Wide-field fundus photograph of an infant; 1240x1240px; 100° field of view (Phoenix ICON):
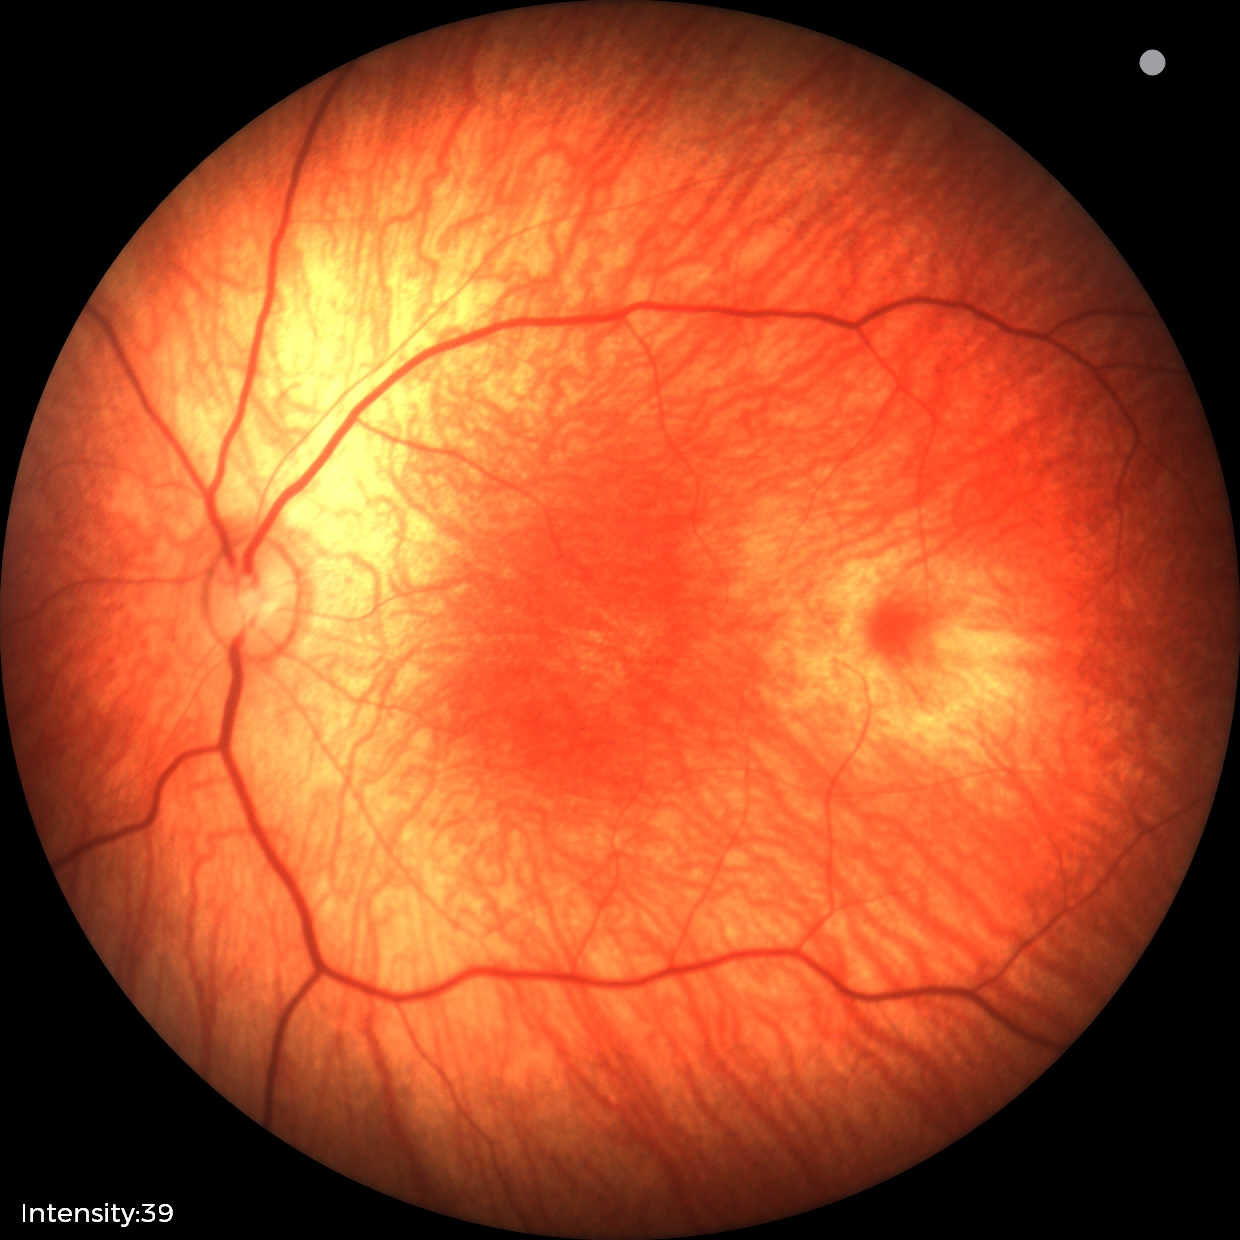

Assessment: physiological appearance.